640x480px · wide-field fundus image from infant ROP screening
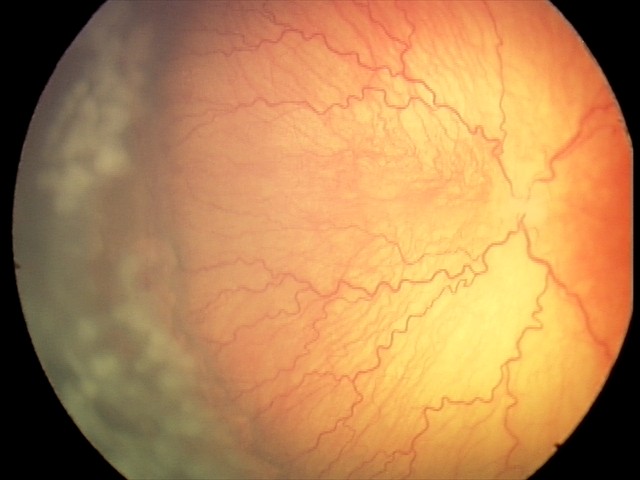 Plus disease was diagnosed. From an examination with diagnosis of aggressive retinopathy of prematurity — rapidly progressive severe ROP with prominent plus disease, often without classic stage progression.